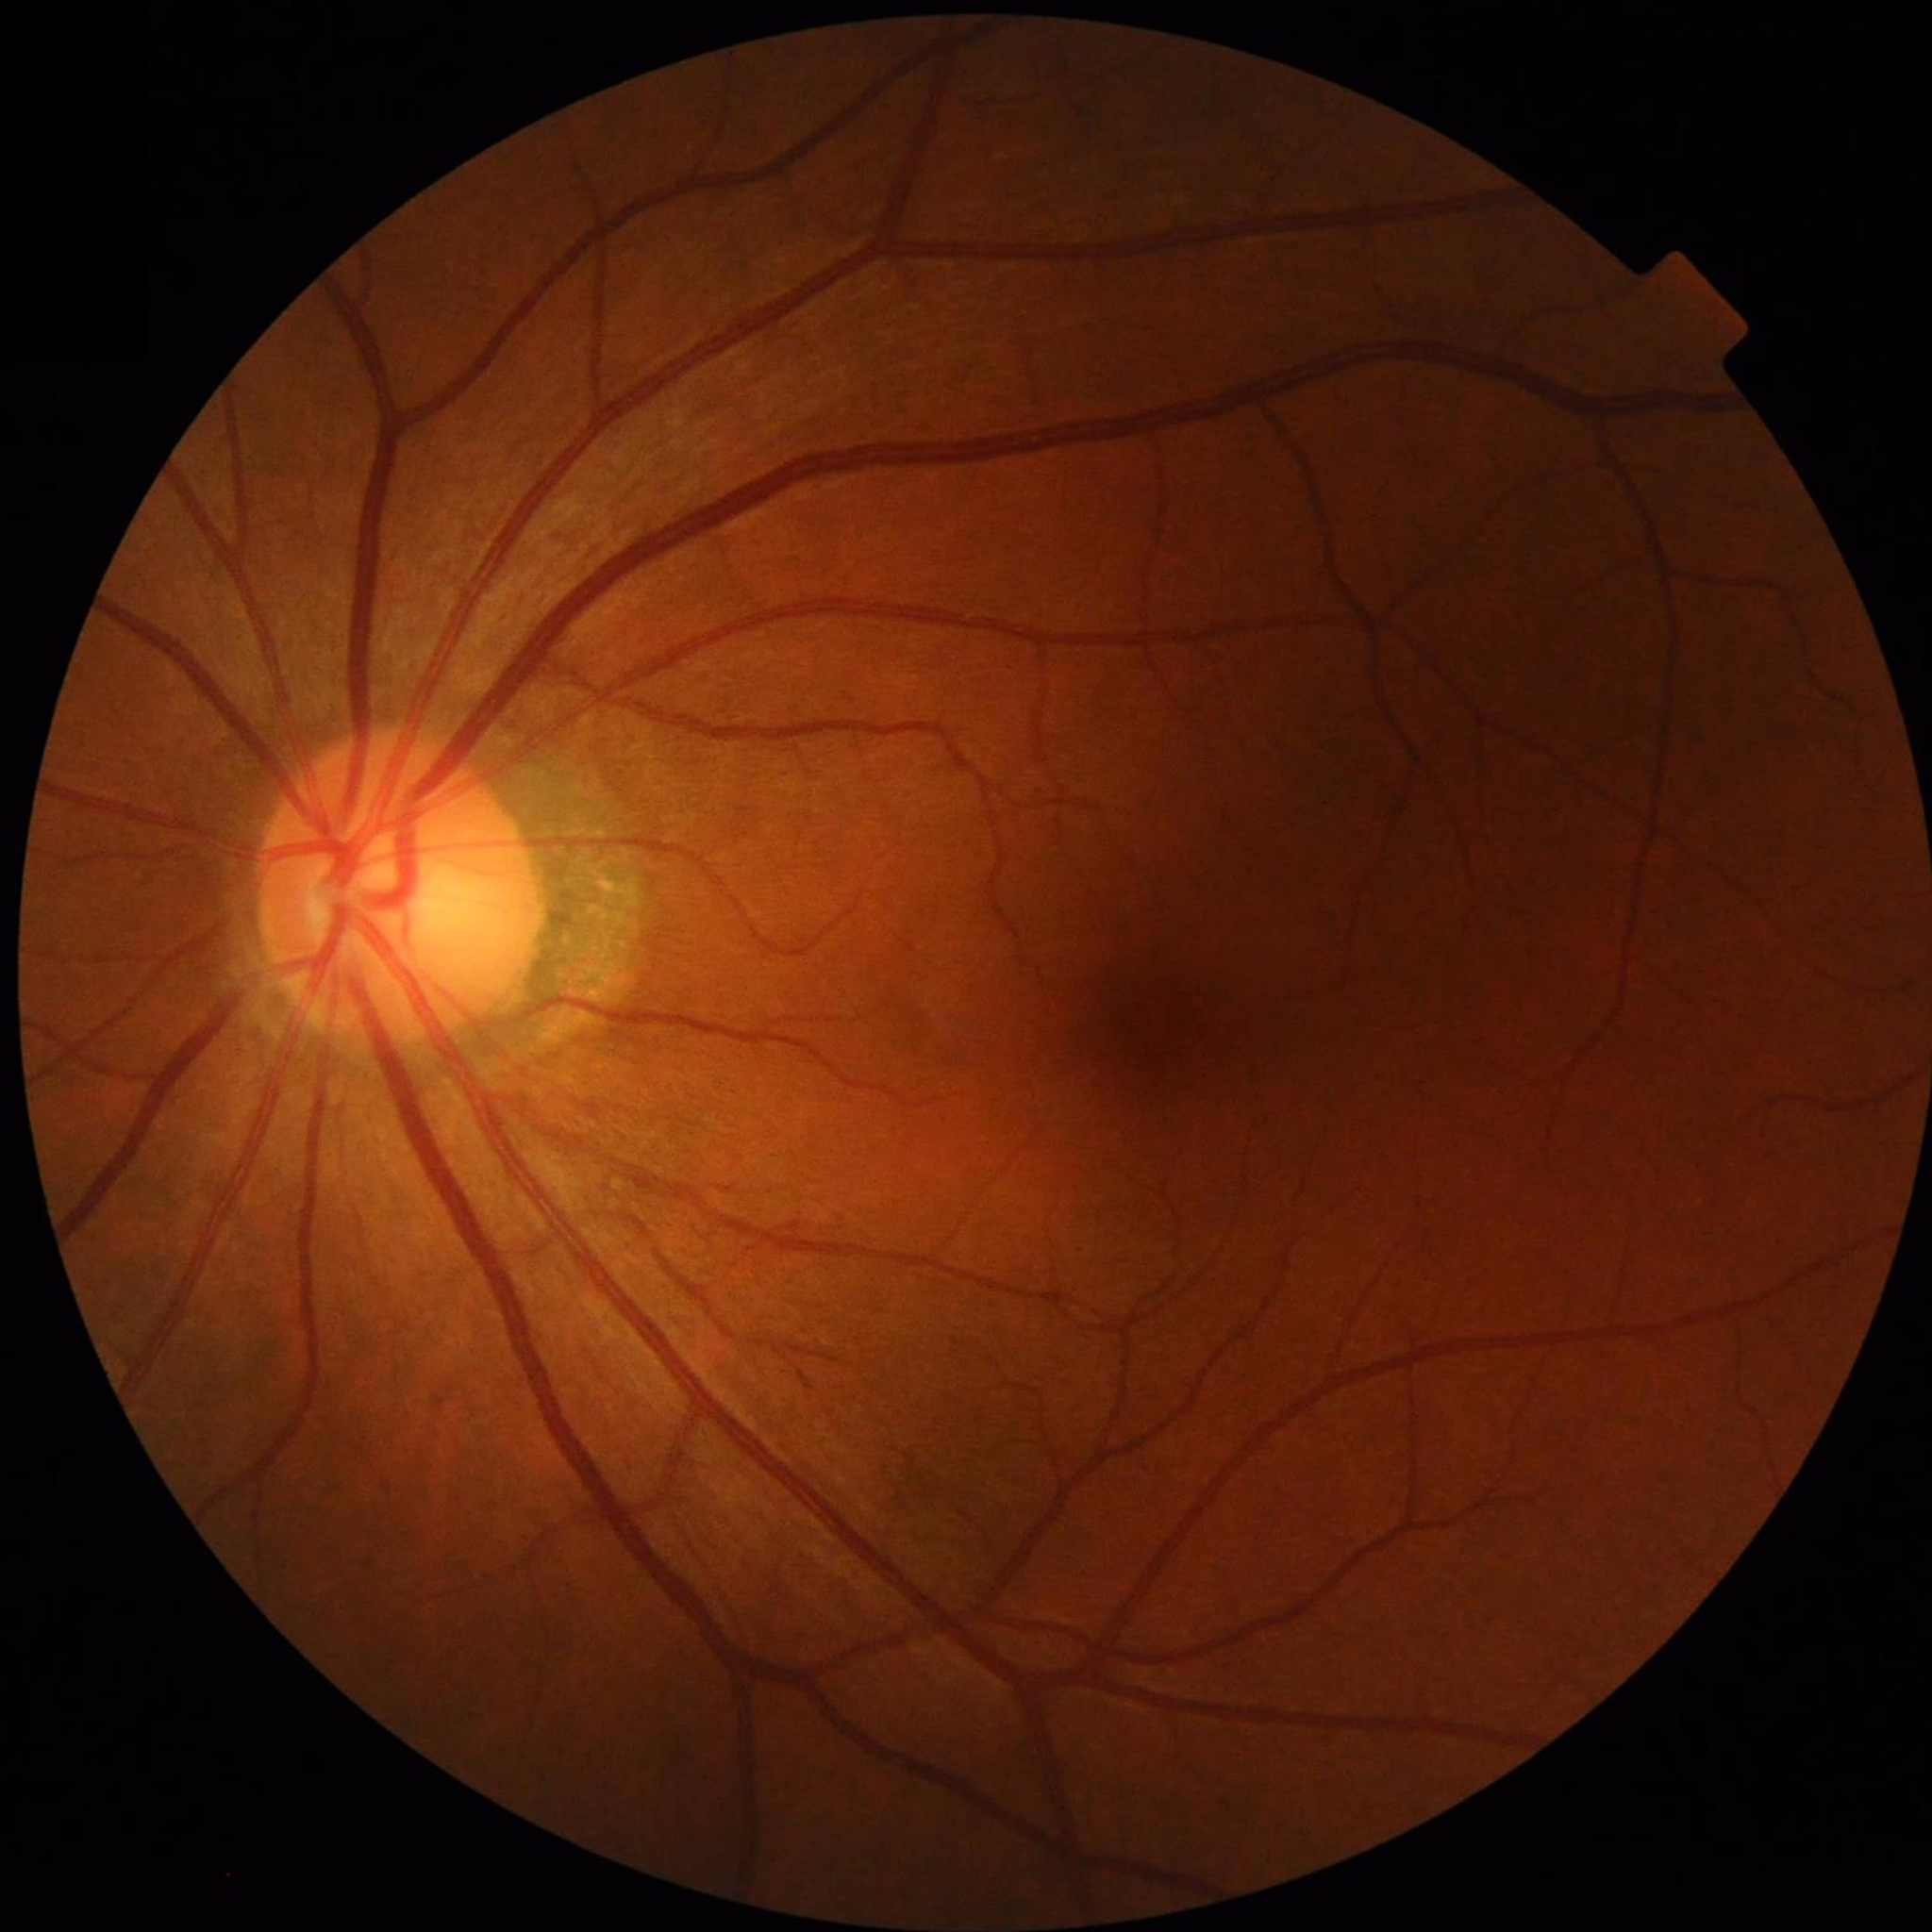
No findings of AMD, diabetic retinopathy, or glaucoma.